Color fundus image: 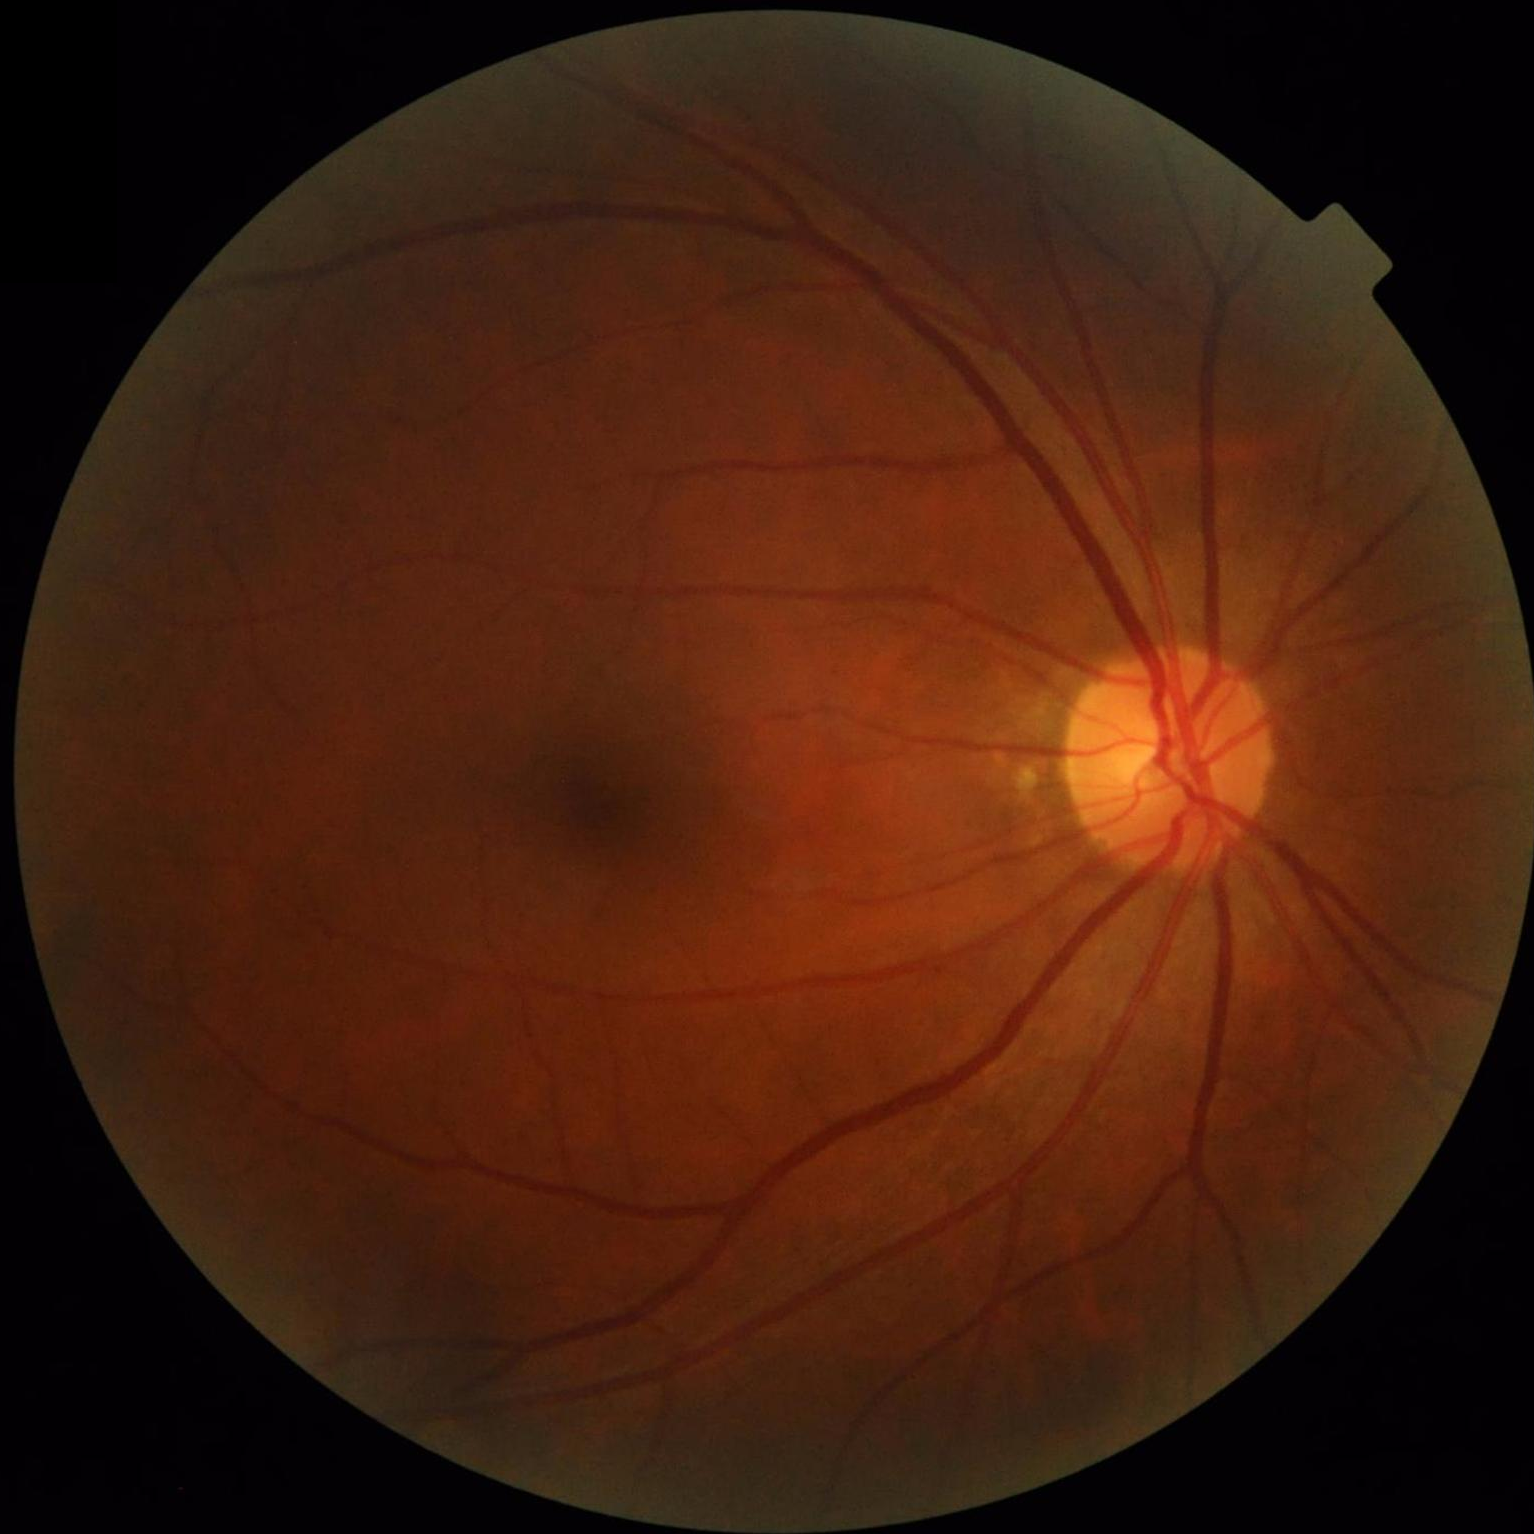

No over- or under-exposure.
Acceptable image quality.
Good dynamic range.